Wide-field fundus image from infant ROP screening.
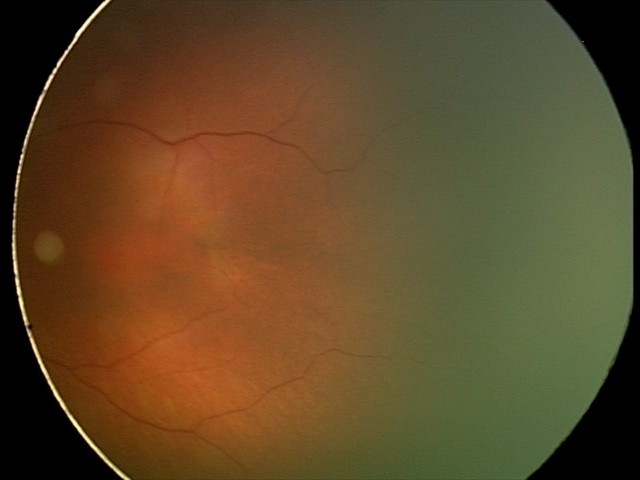 Normal screening examination.